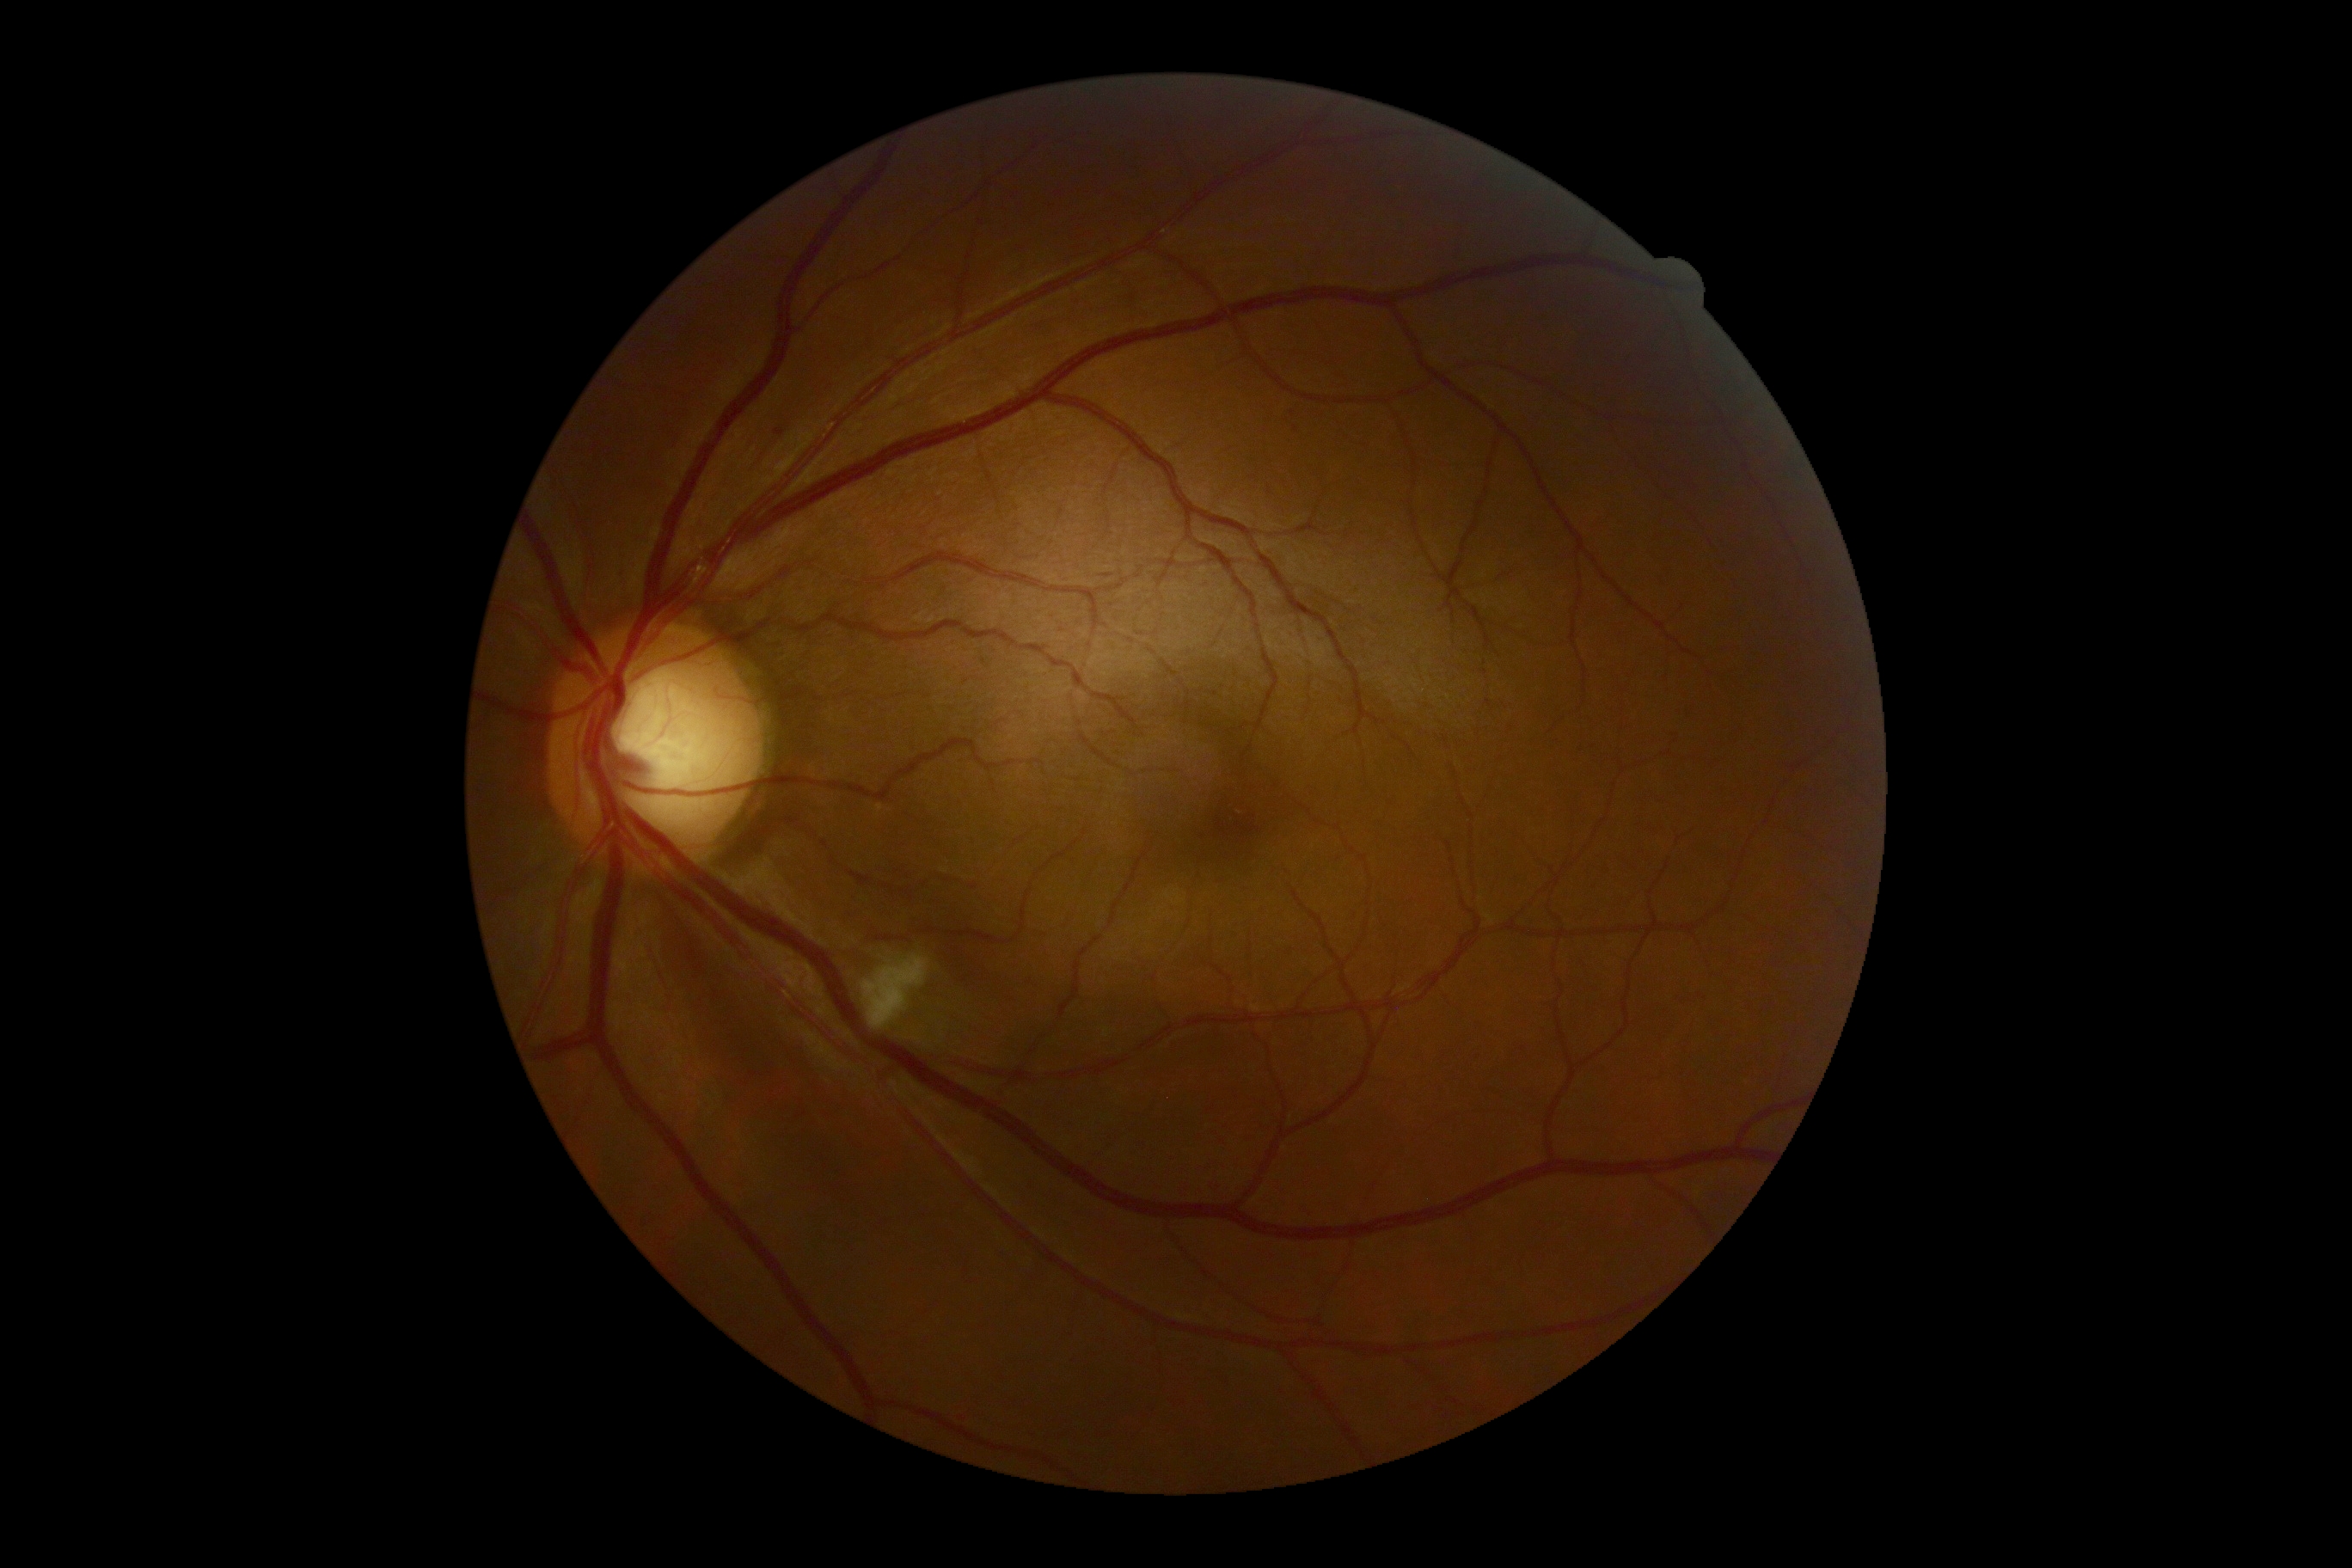

diabetic retinopathy=2.